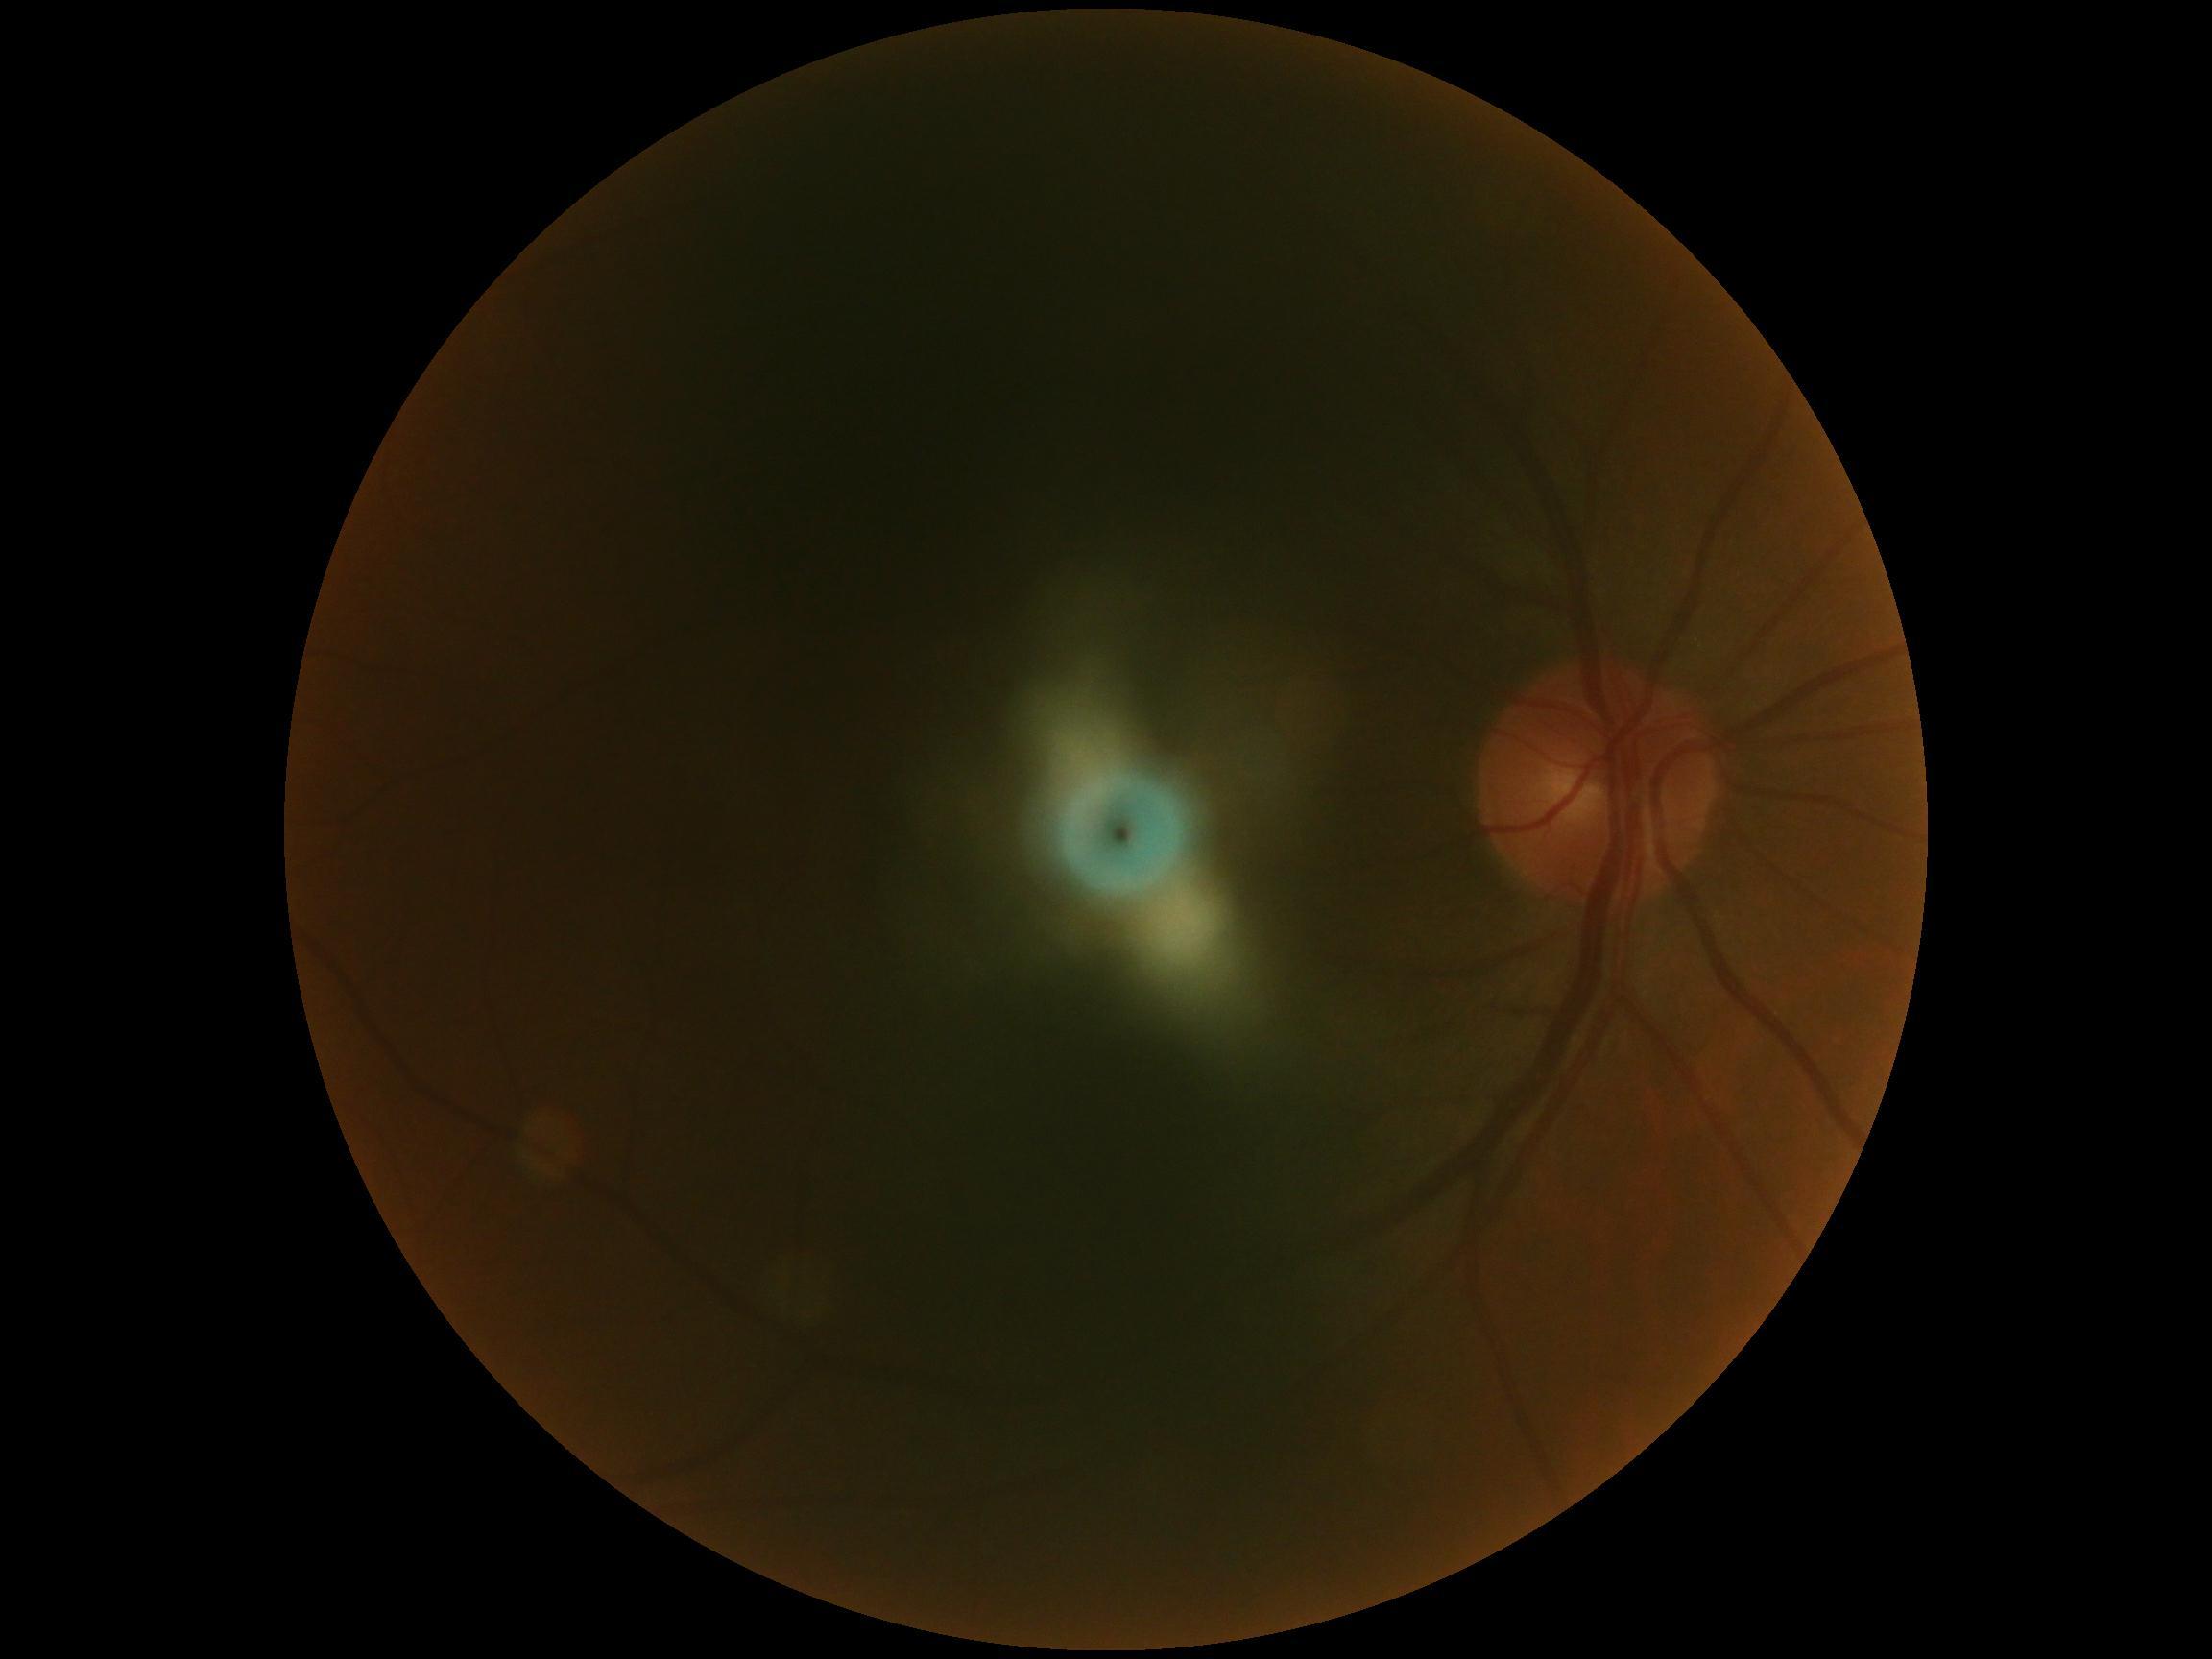
DR = ungradable due to poor image quality